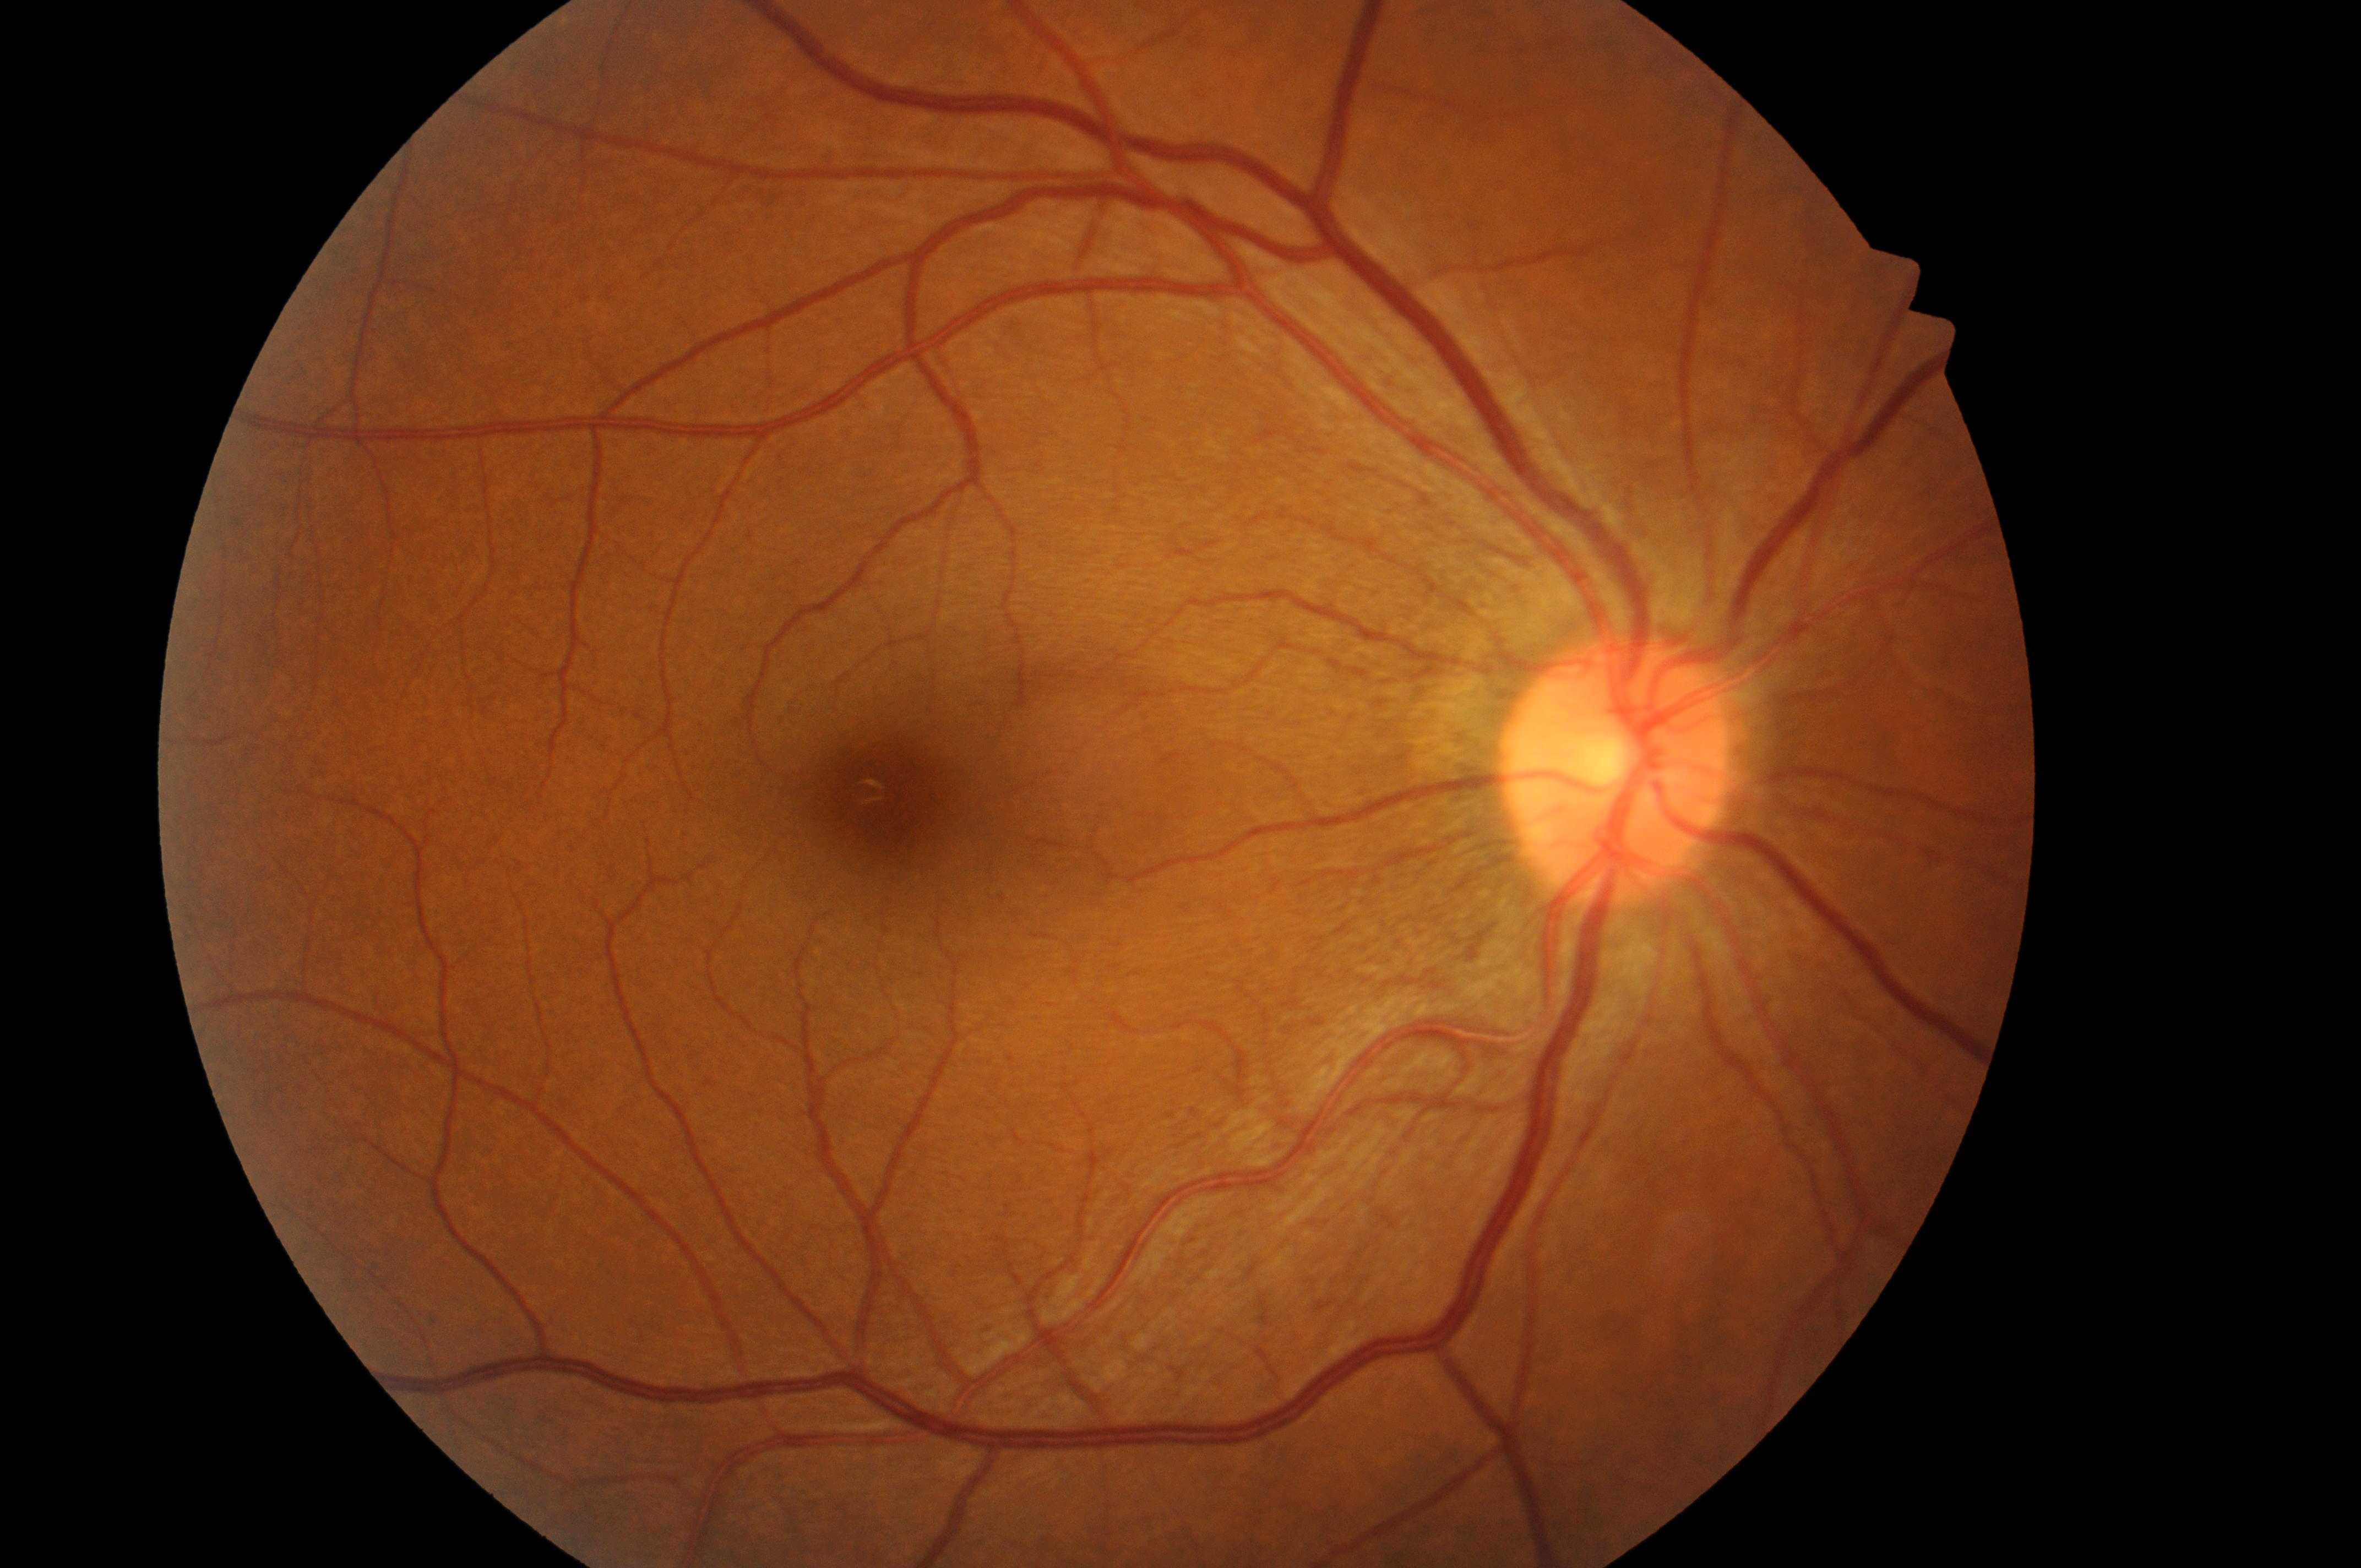

Eye: OD.
Disc center: (x: 1615, y: 777).
Macula center located at (x: 889, y: 806).
Retinopathy: no apparent retinopathy (grade 0).
Risk of macular edema: no risk (grade 0).